FOV: 45 degrees, color fundus photograph
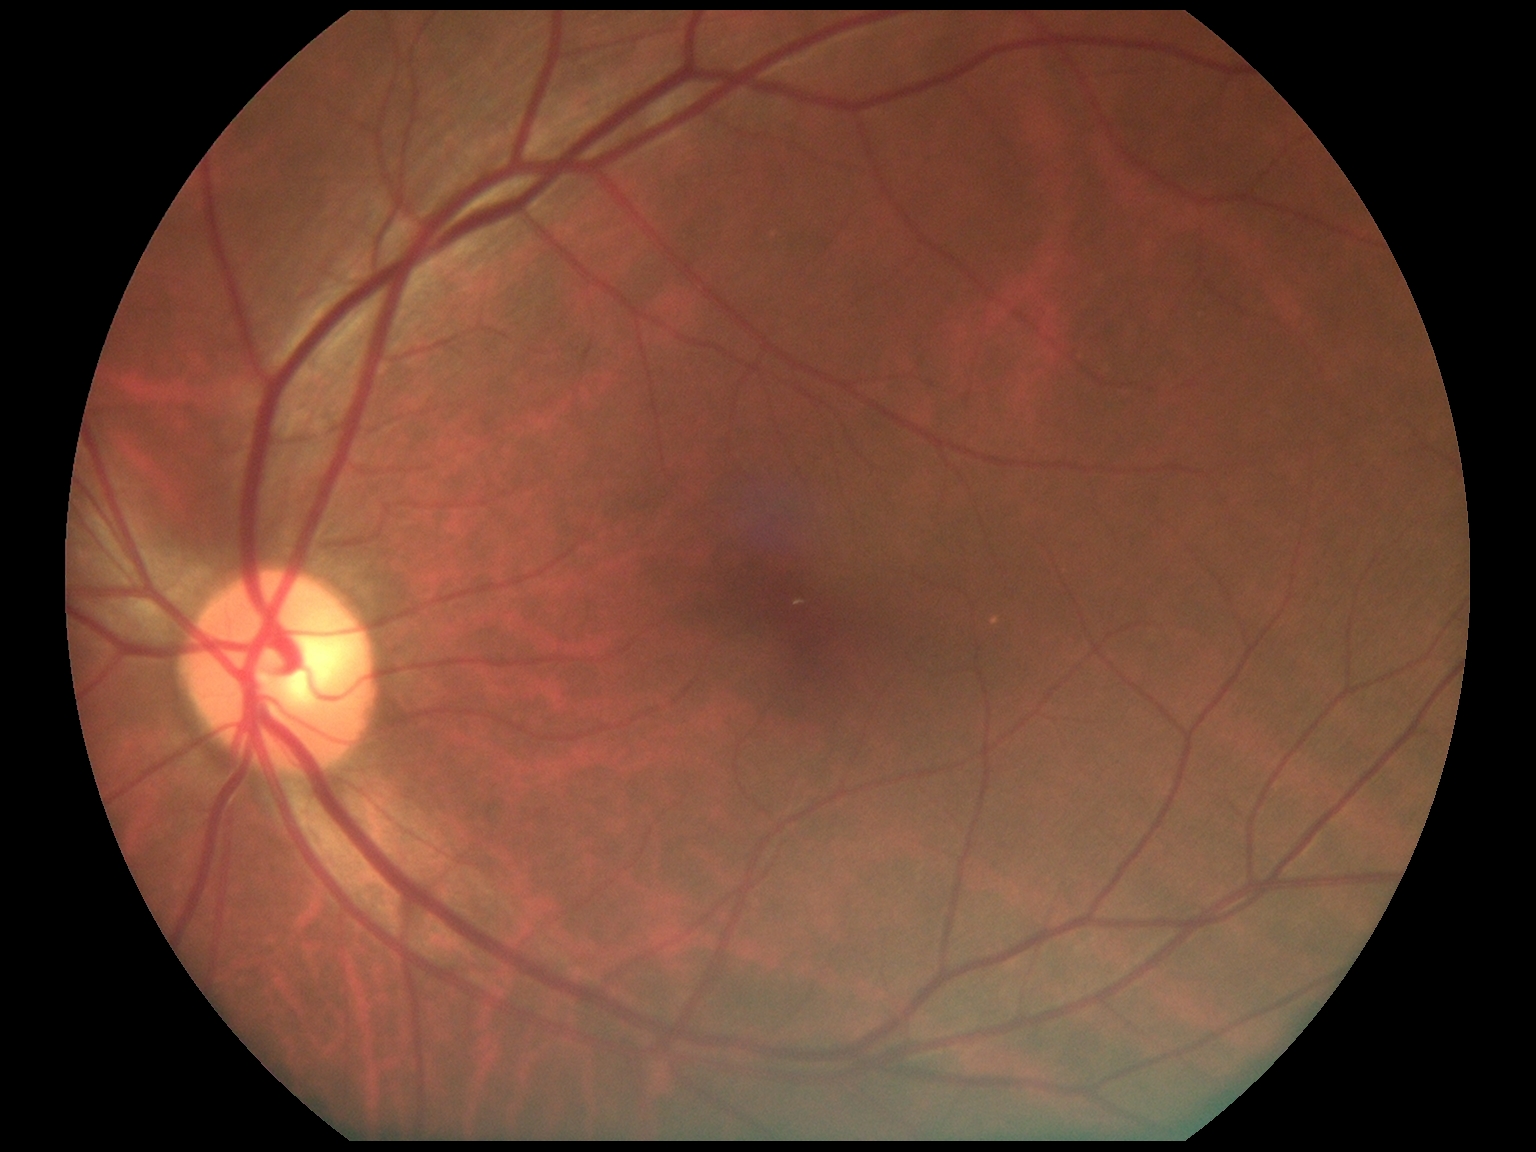
DR grade is 0.